Clarity RetCam 3, 130° FOV. Wide-field contact fundus photograph of an infant — 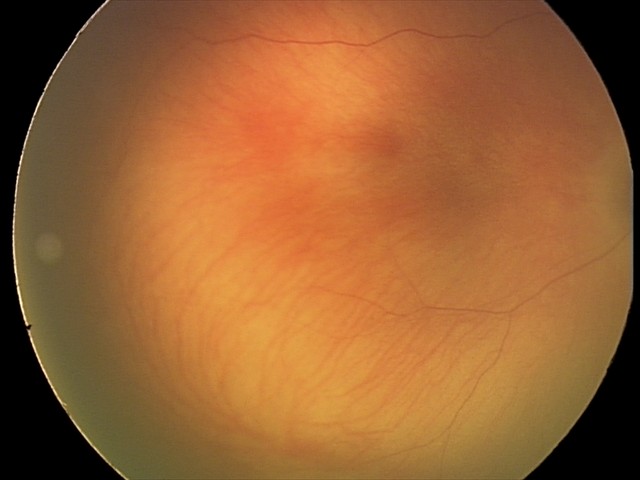 Finding: no pathology identified.